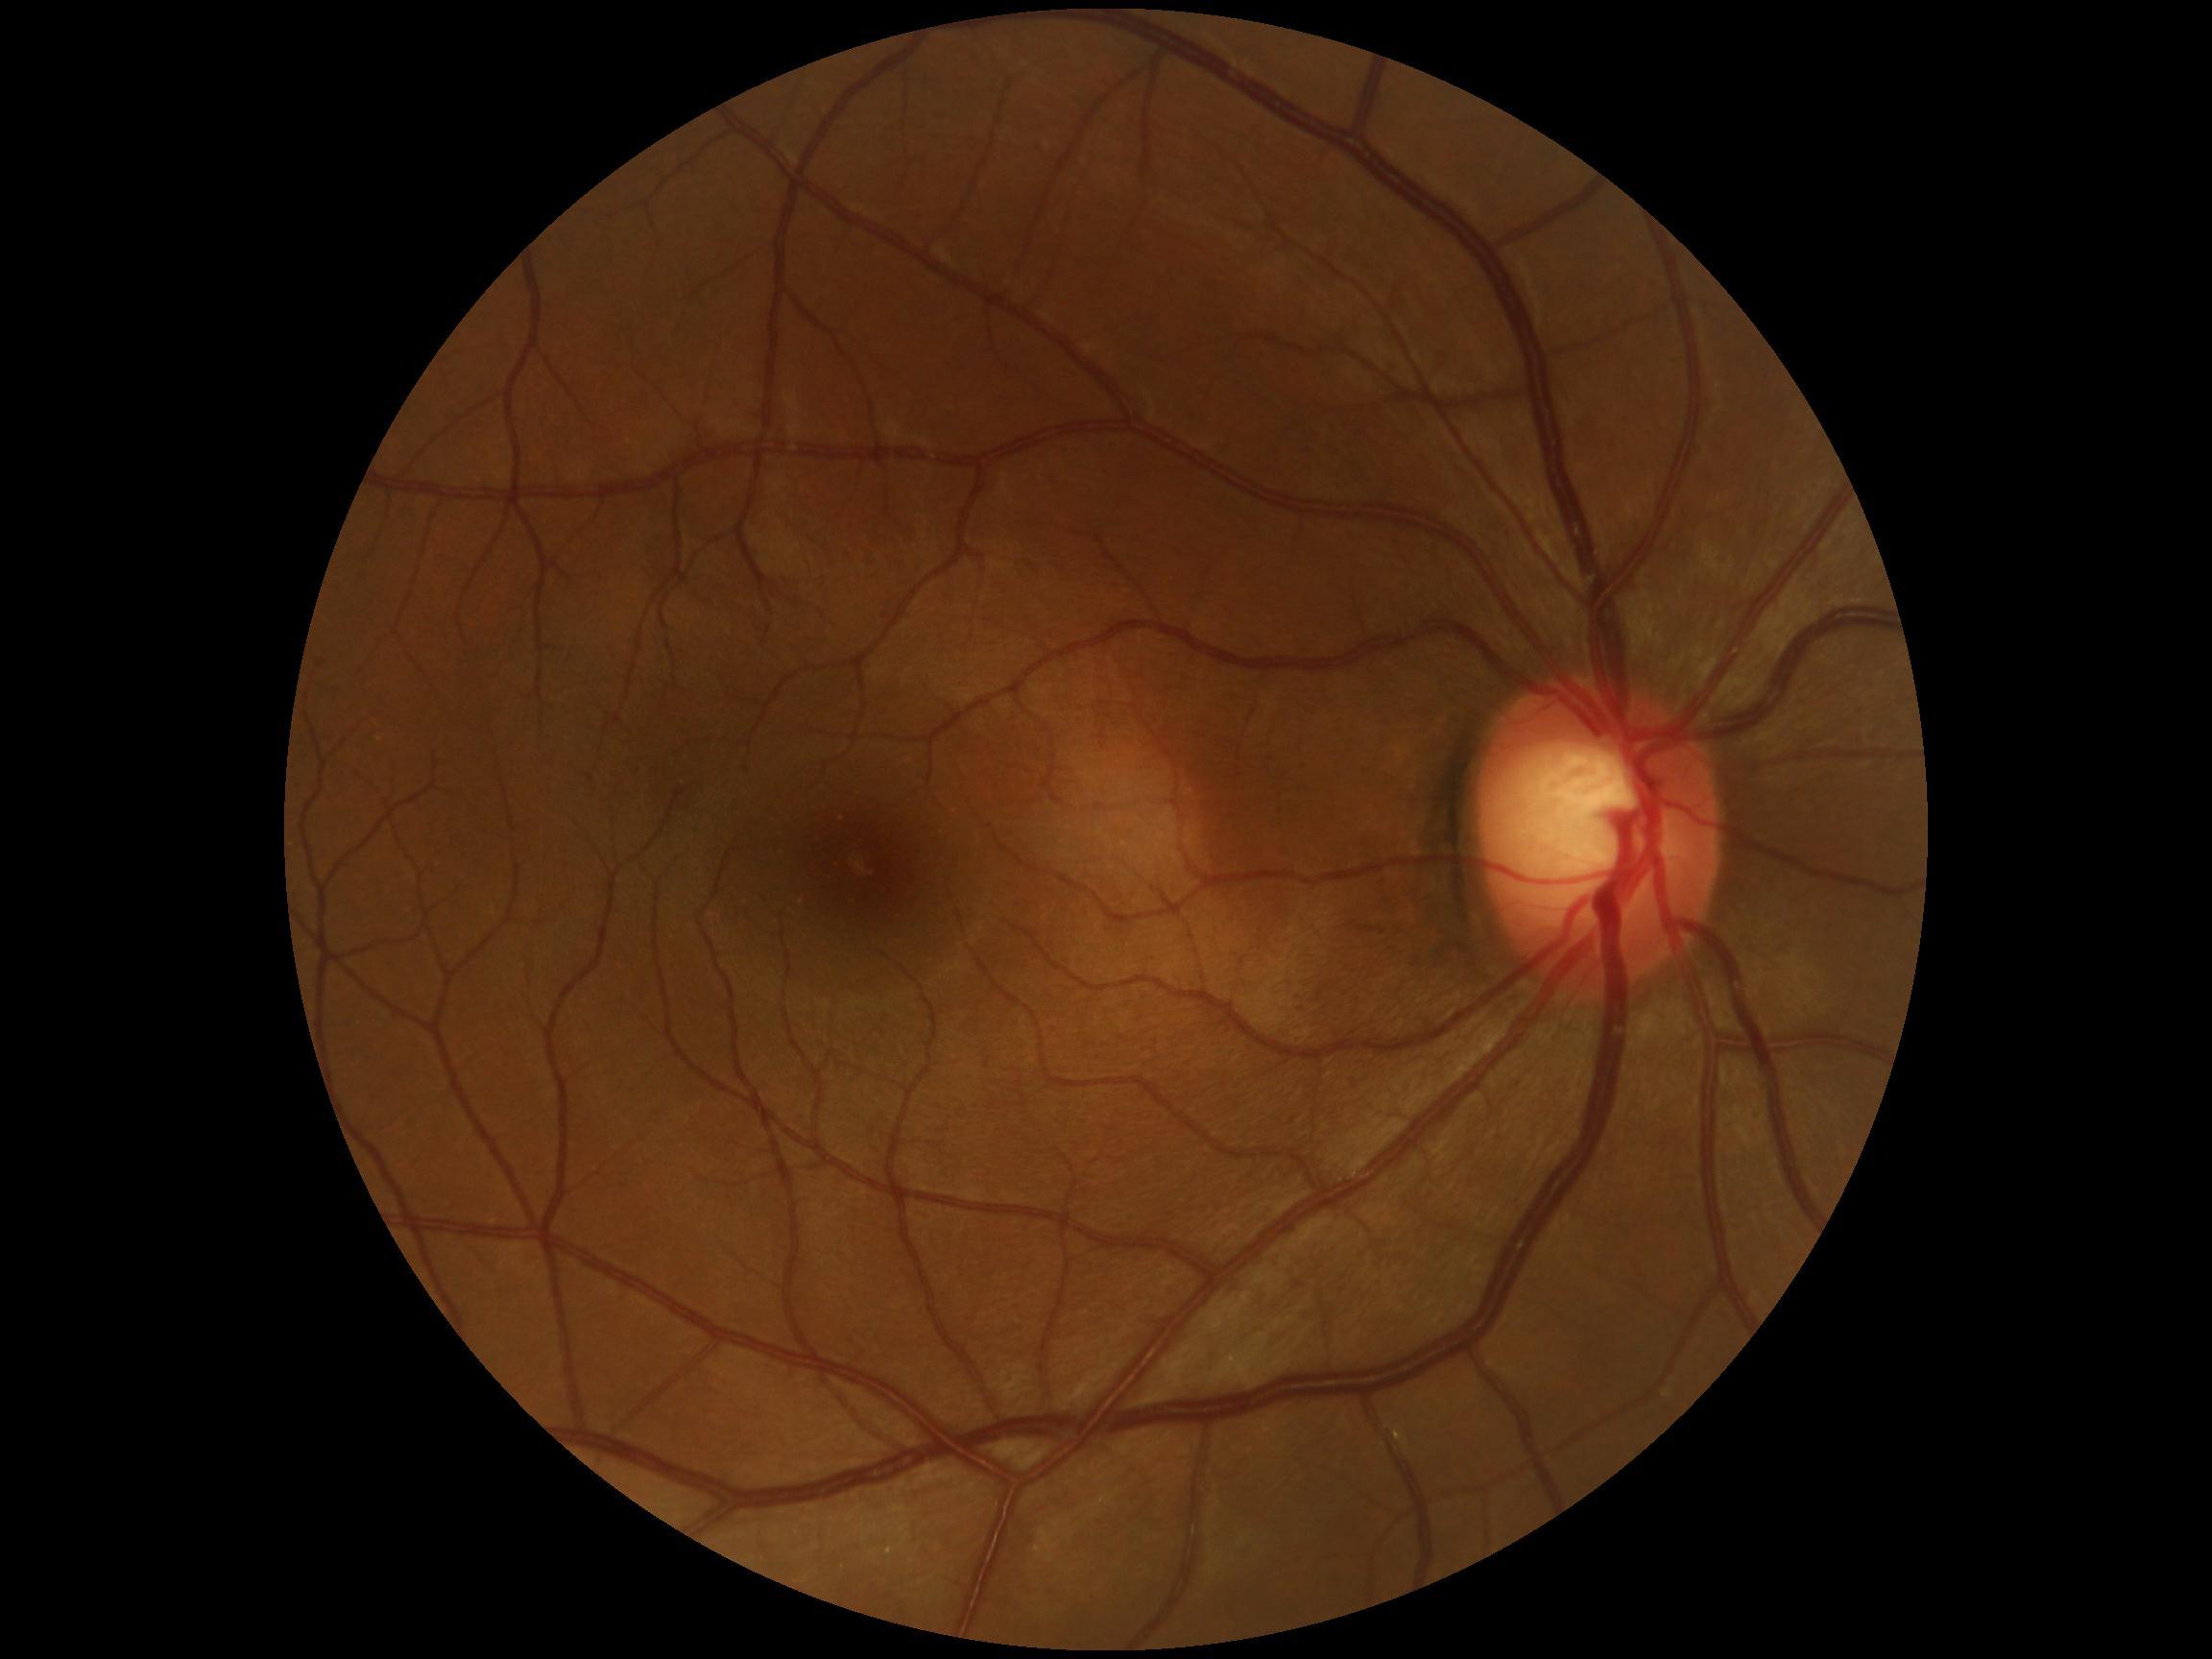
Diabetic retinopathy severity: 0 — no visible signs of diabetic retinopathy.